Nonmydriatic fundus photograph · retinal fundus photograph · NIDEK AFC-230 fundus camera · 45° field of view
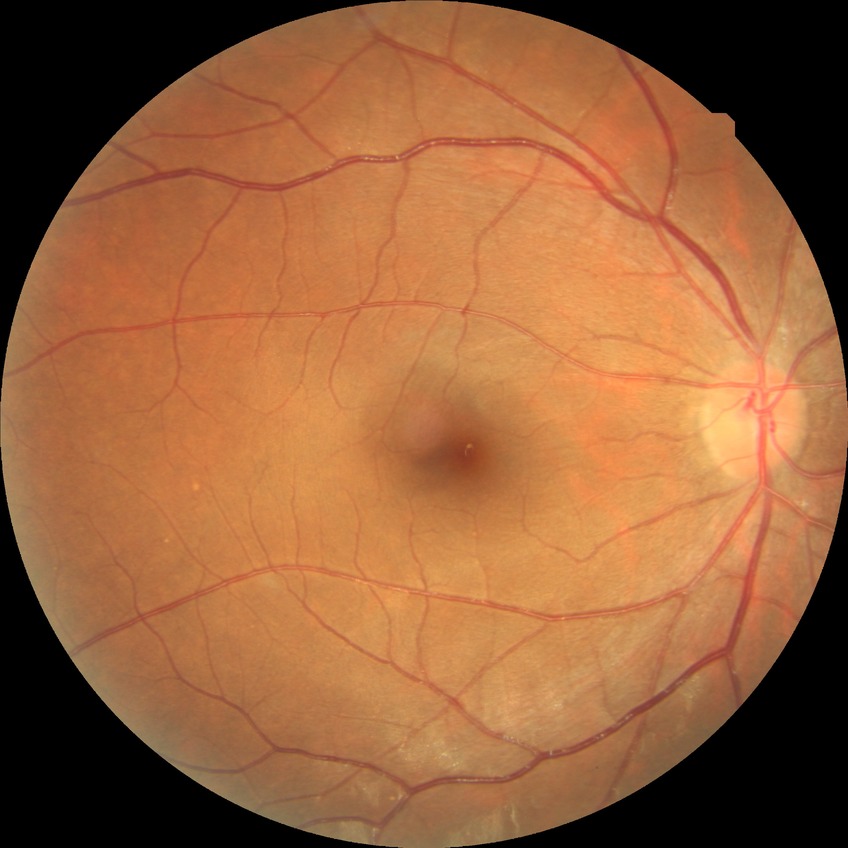
Diabetic retinopathy (DR) is NDR (no diabetic retinopathy).